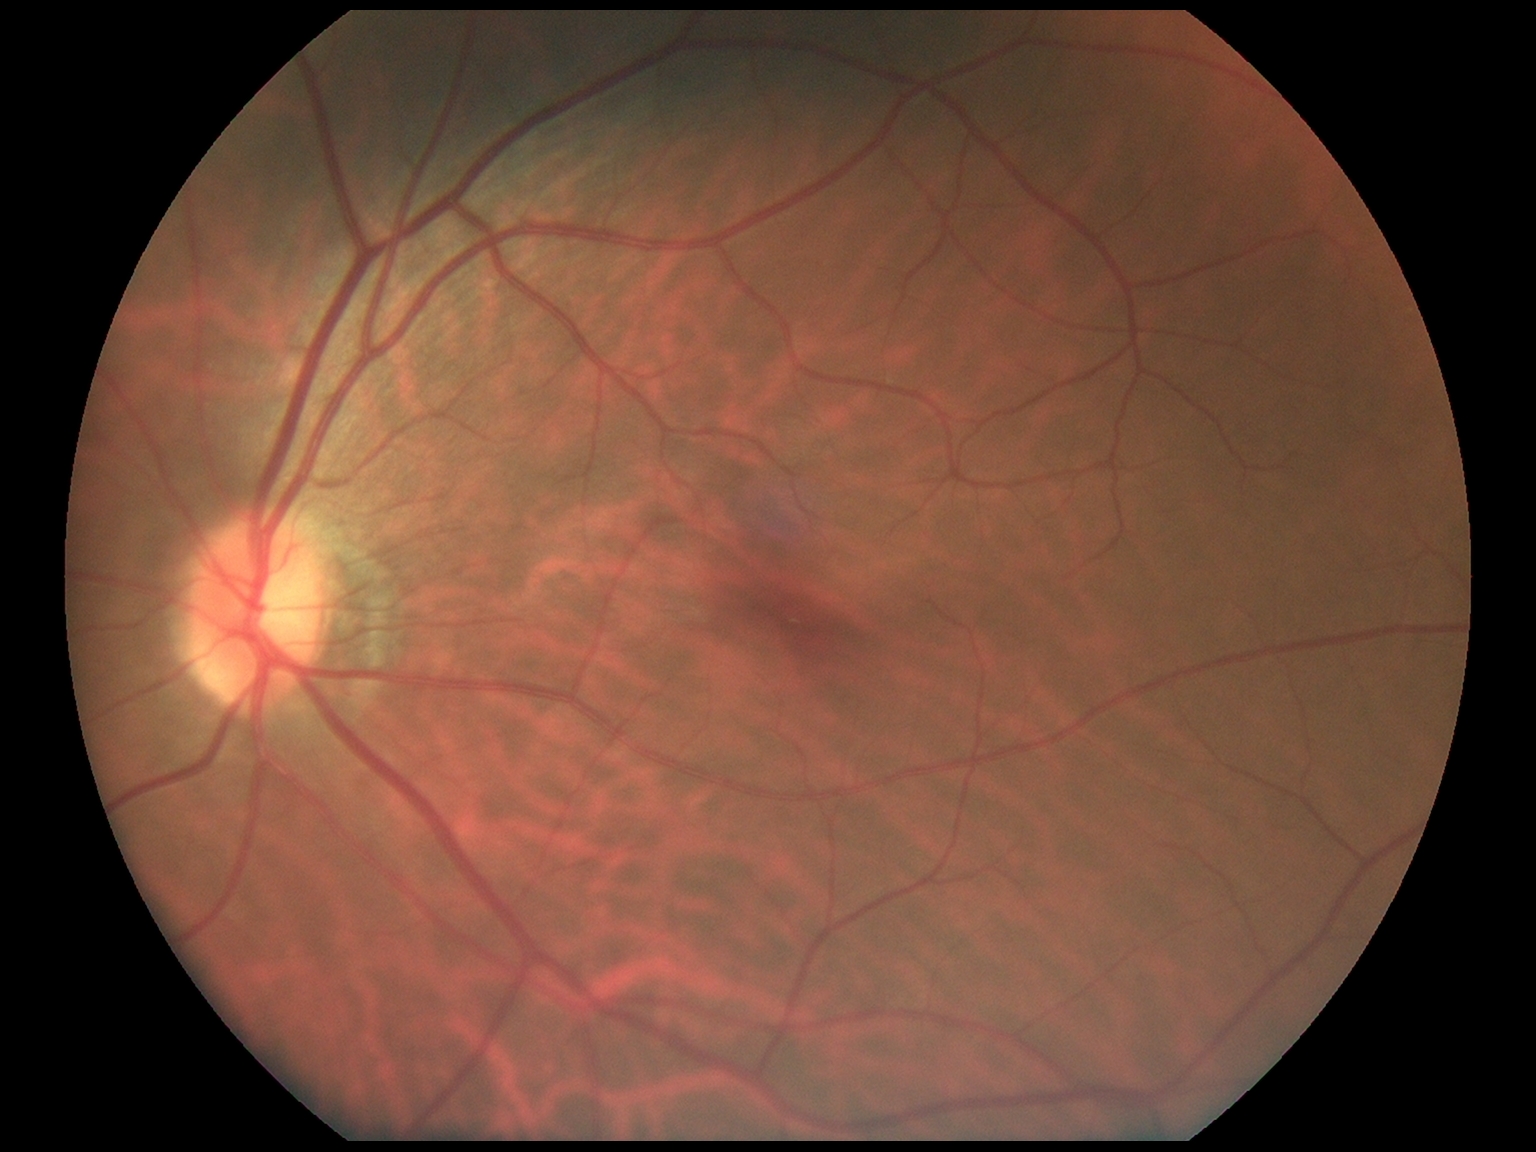

No apparent diabetic retinopathy.
Diabetic retinopathy (DR) is 0.